Color fundus image:
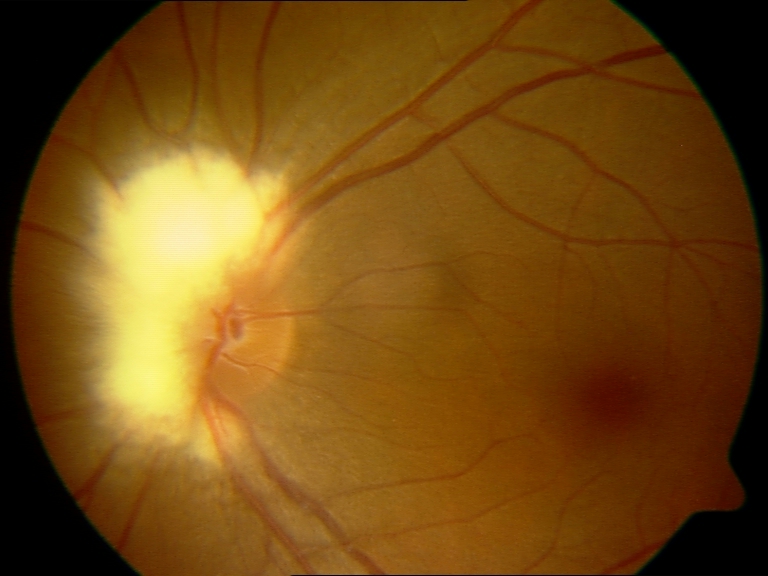 Findings consistent with myelinated nerve fibers.